Fundus photo. Modified Davis grading. No pharmacologic dilation. 848x848.
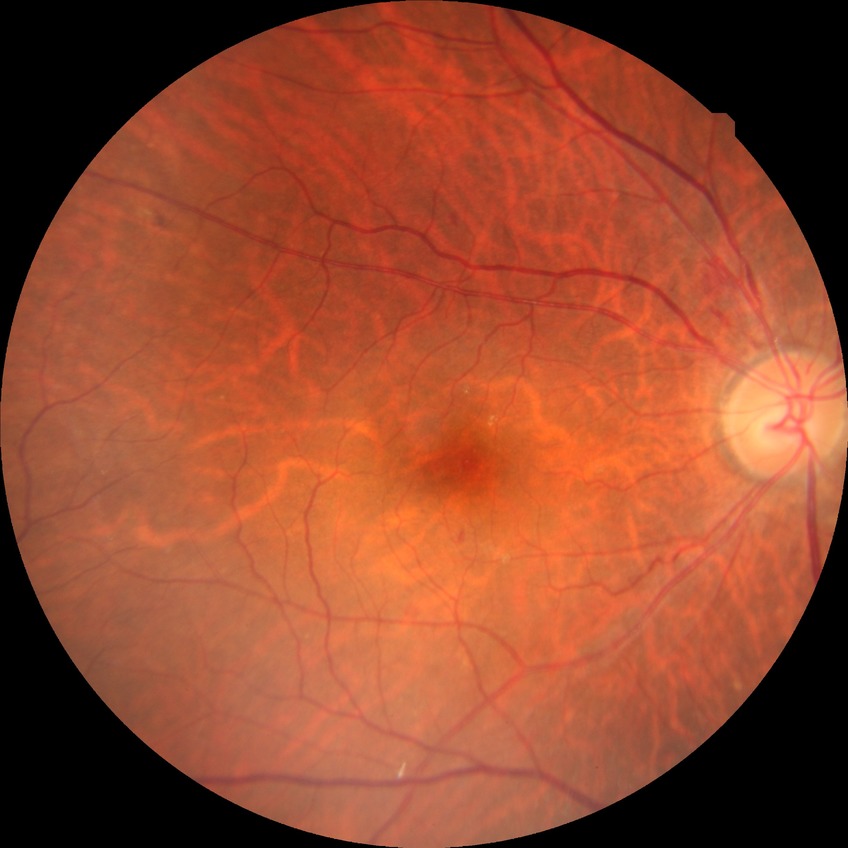

diabetic retinopathy (DR)@simple diabetic retinopathy (SDR).